1659x2212:
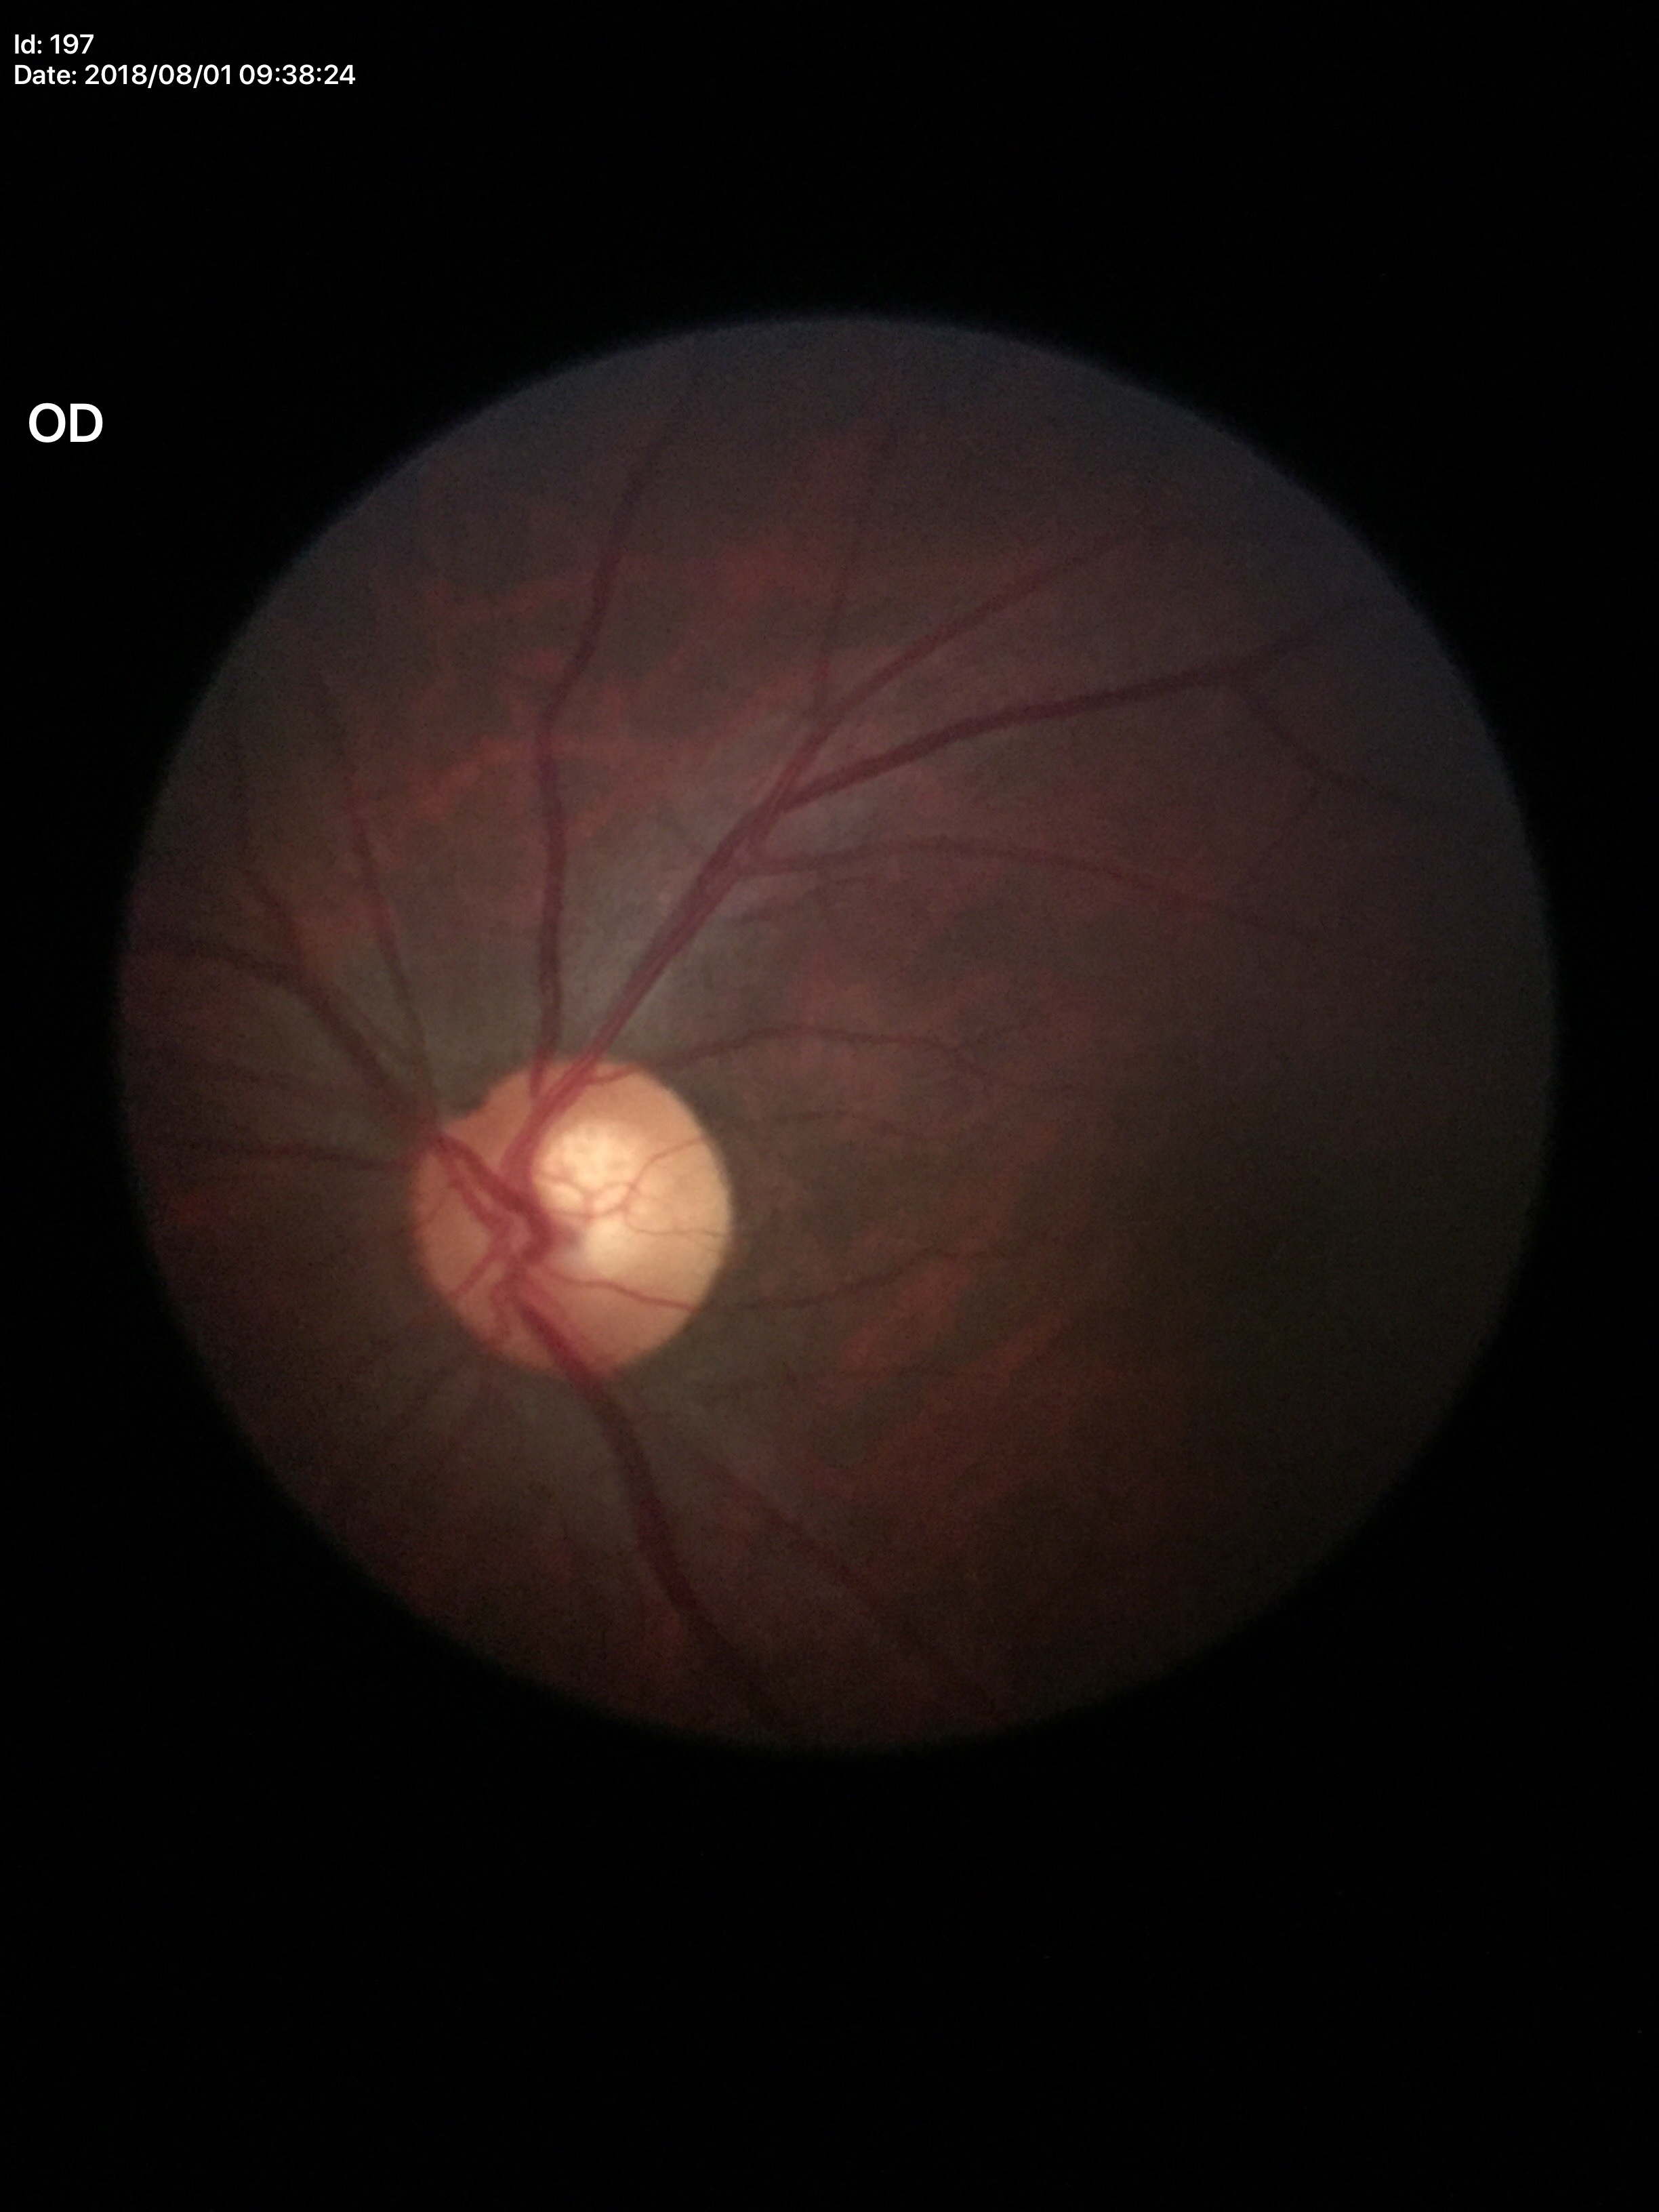 No evidence of glaucoma (one of five ophthalmologists flagged glaucoma suspect).
VCDR: 0.58.